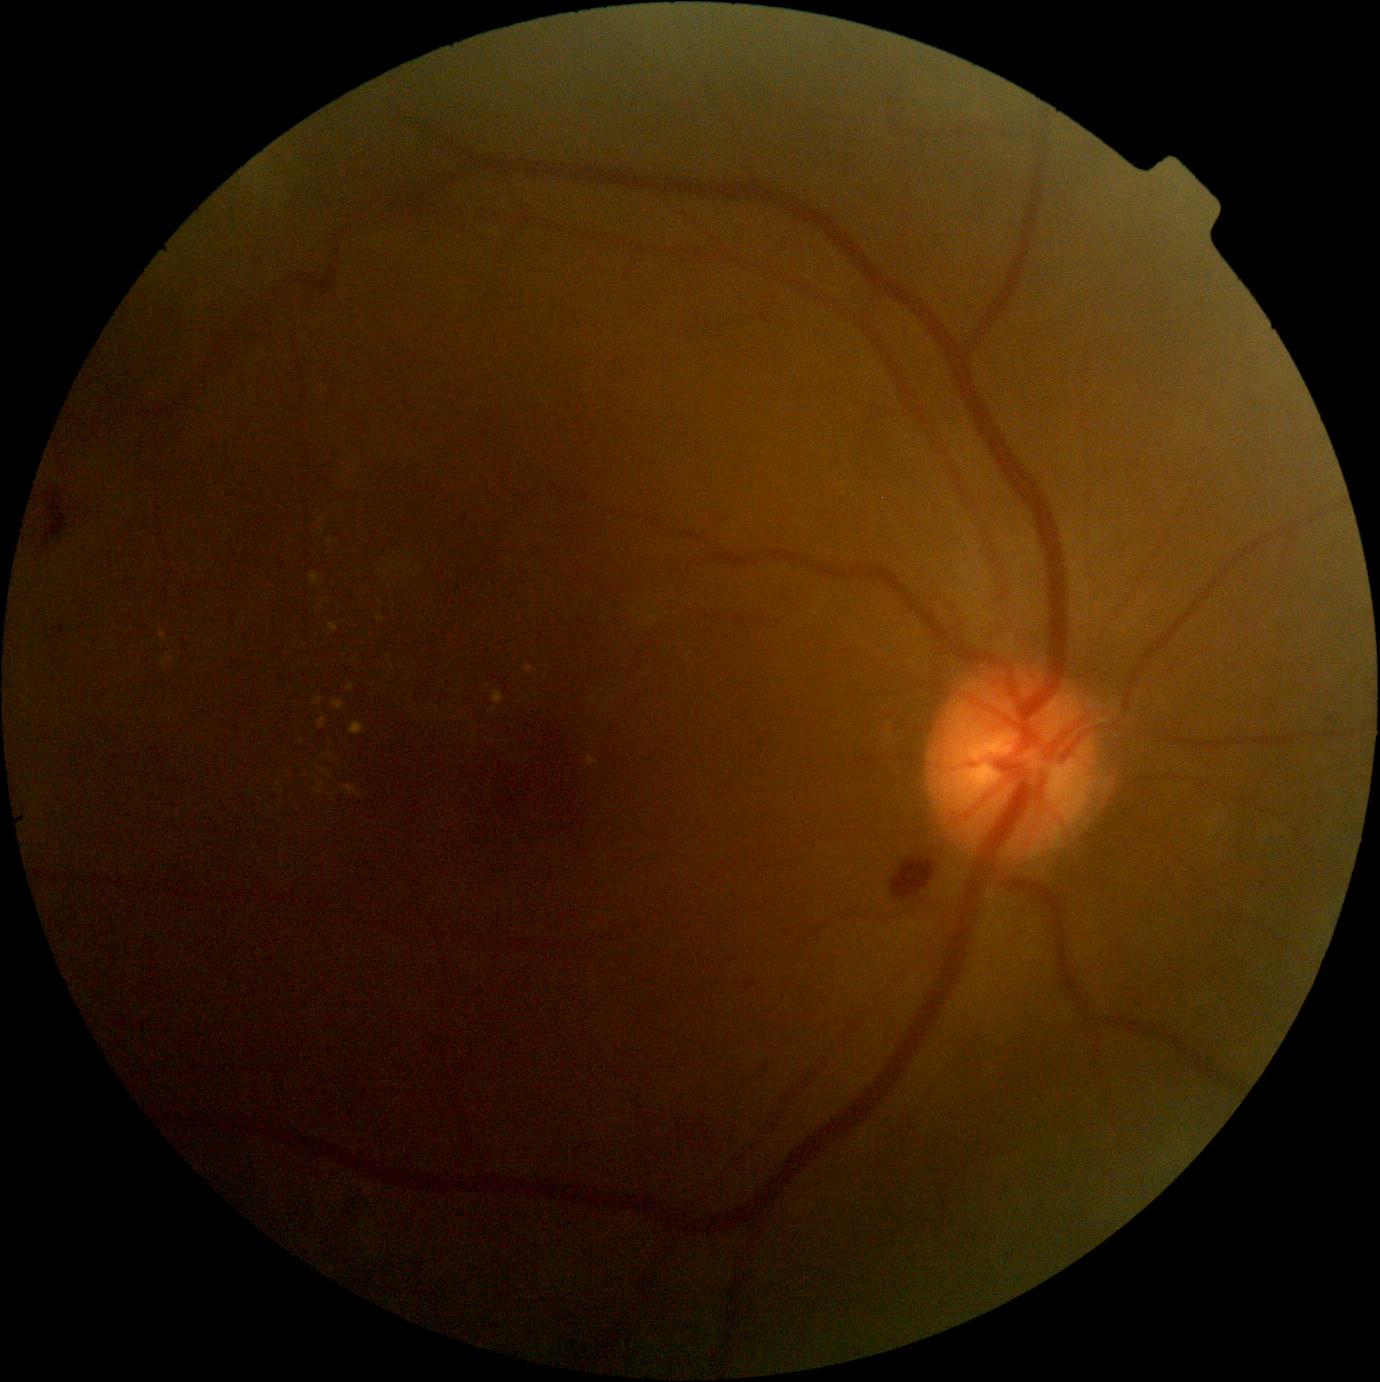
Diabetic retinopathy (DR) is 2; non-proliferative diabetic retinopathy
Representative lesions:
hard exudates (EXs) (more not shown): (328,625,339,633) | (315,790,323,794) | (348,684,354,692) | (312,697,324,707) | (493,692,504,705) | (587,757,598,766) | (310,573,319,586) | (160,633,167,641)
Small EXs approximately at {"x": 393, "y": 667} | {"x": 493, "y": 711} | {"x": 331, "y": 543} | {"x": 162, "y": 661} | {"x": 321, "y": 520}